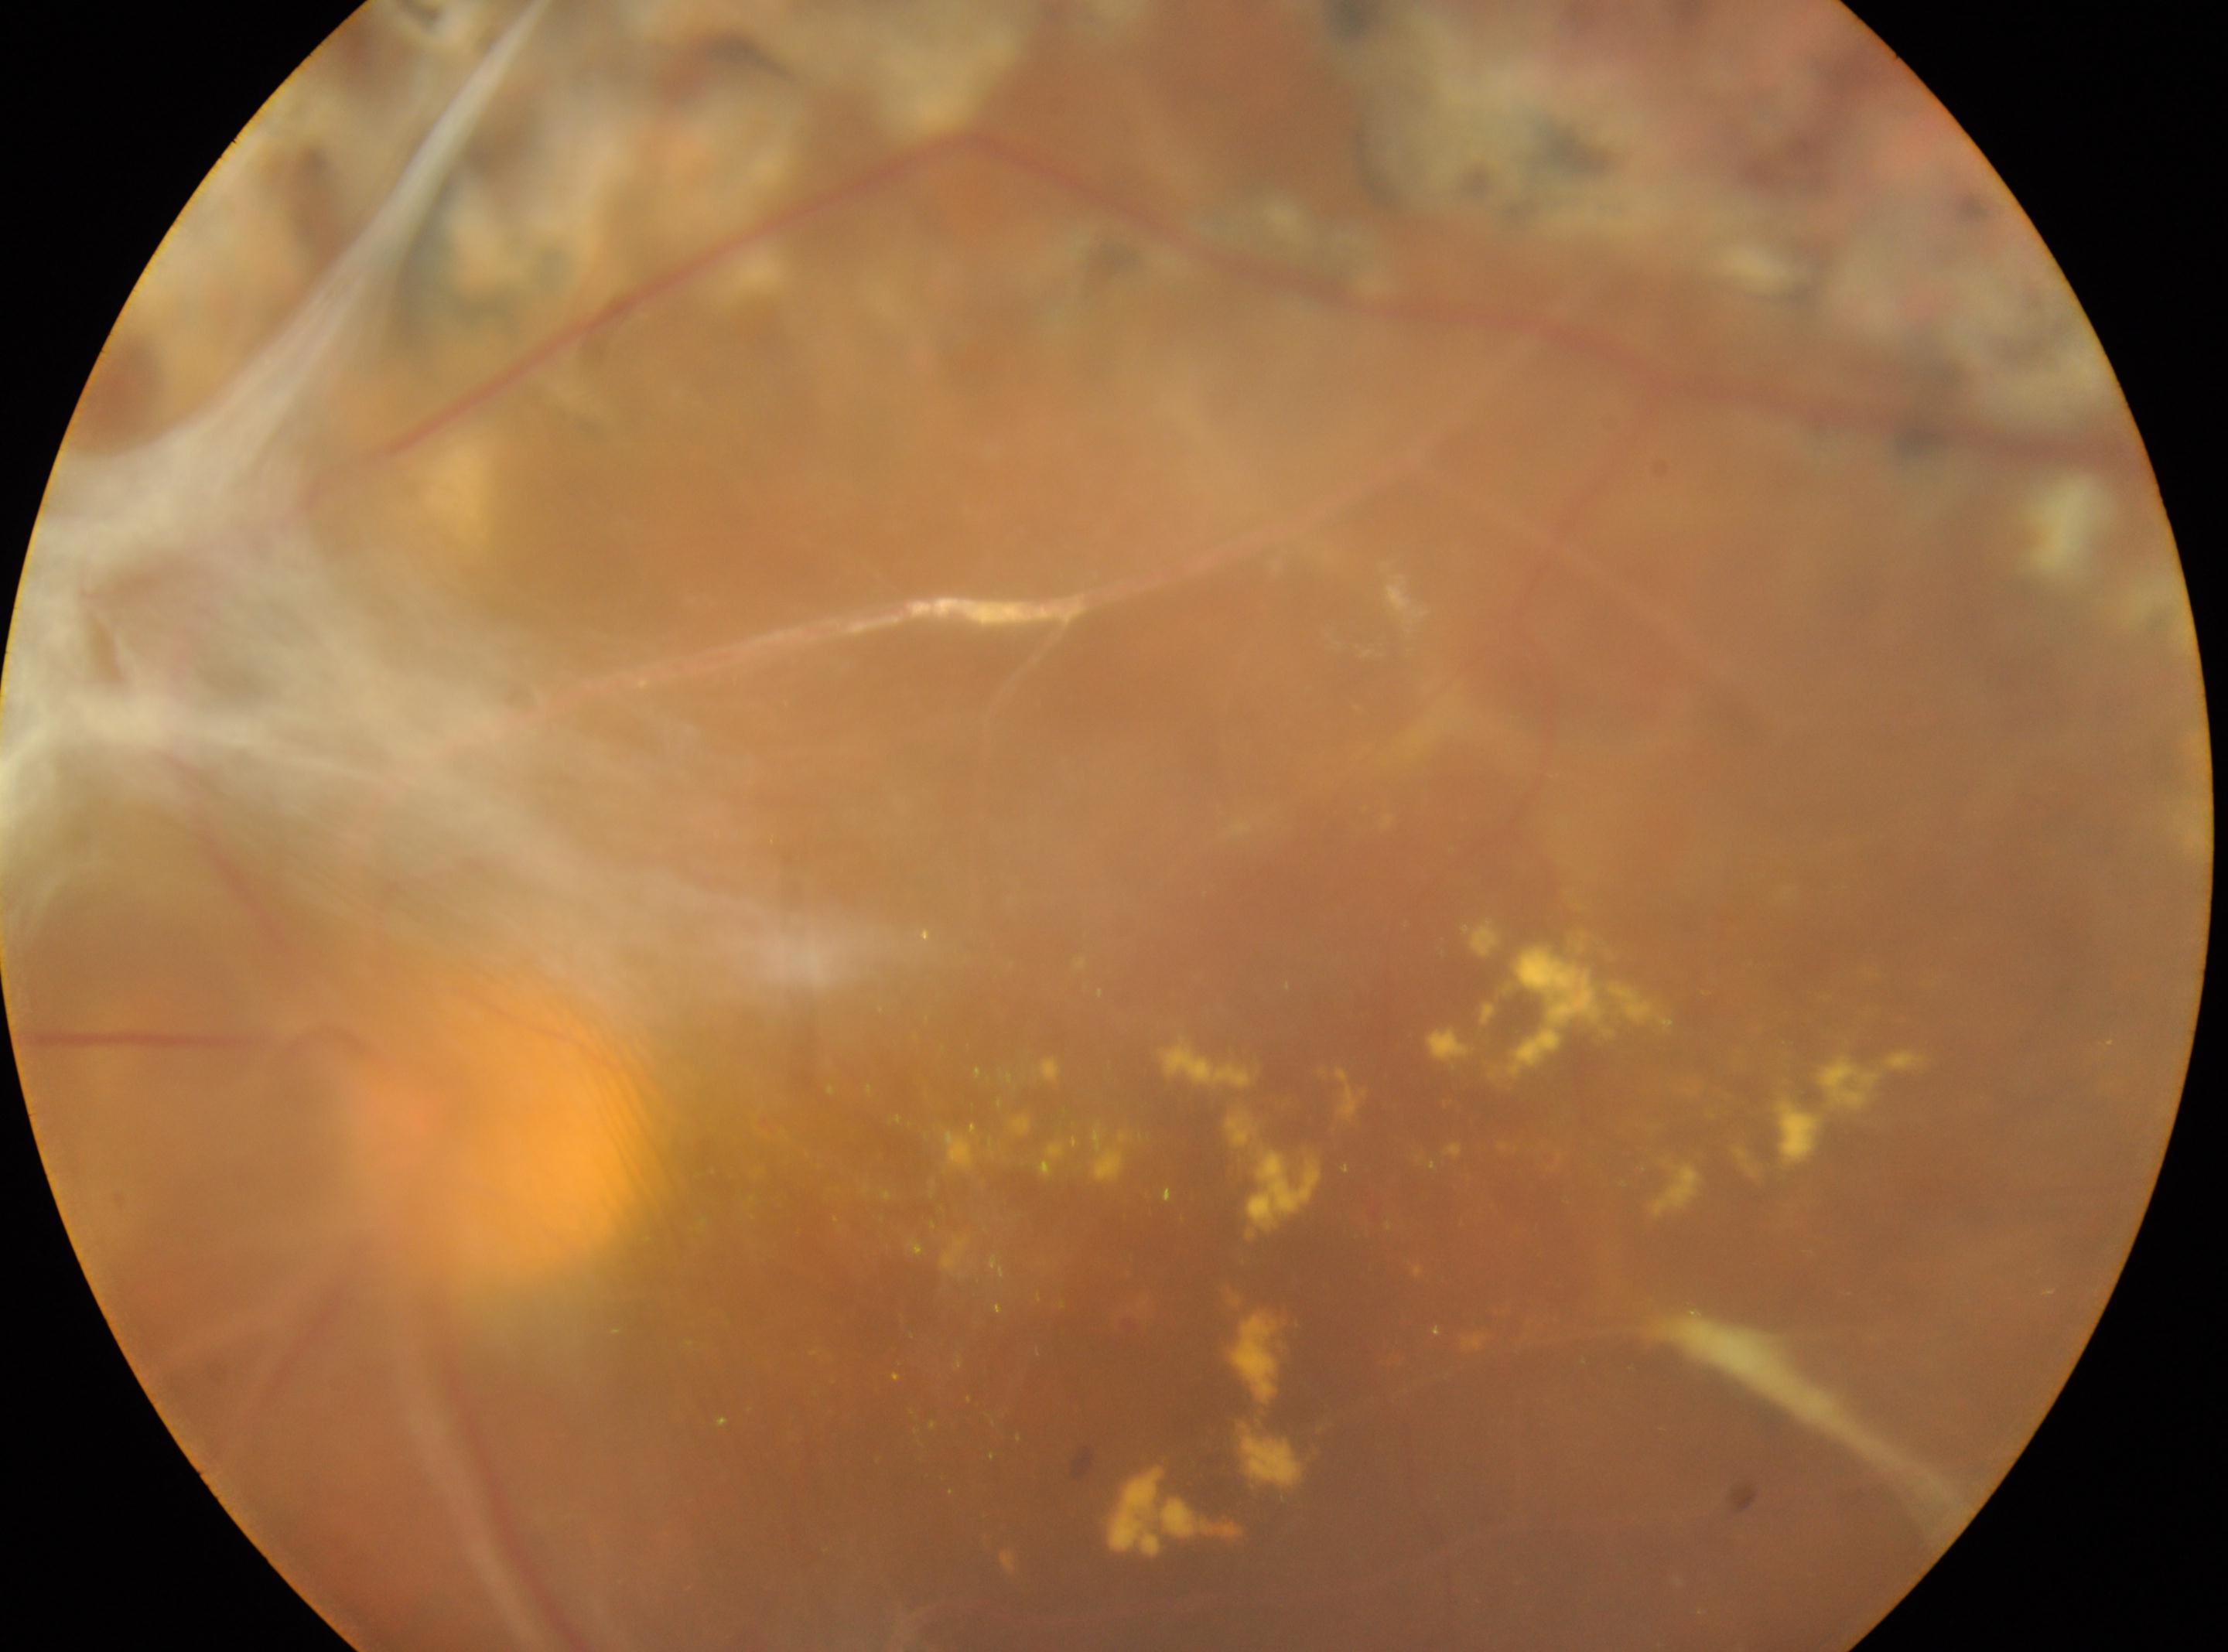 Foveal center: 1310px, 1262px.
DR: post-laser DR, underlying severity grade 4 (PDR).
Eye: the left eye.
The optic disc center is at 501px, 1121px.